Wide-field fundus photograph of an infant; 1440x1080; captured with the Natus RetCam Envision (130° field of view)
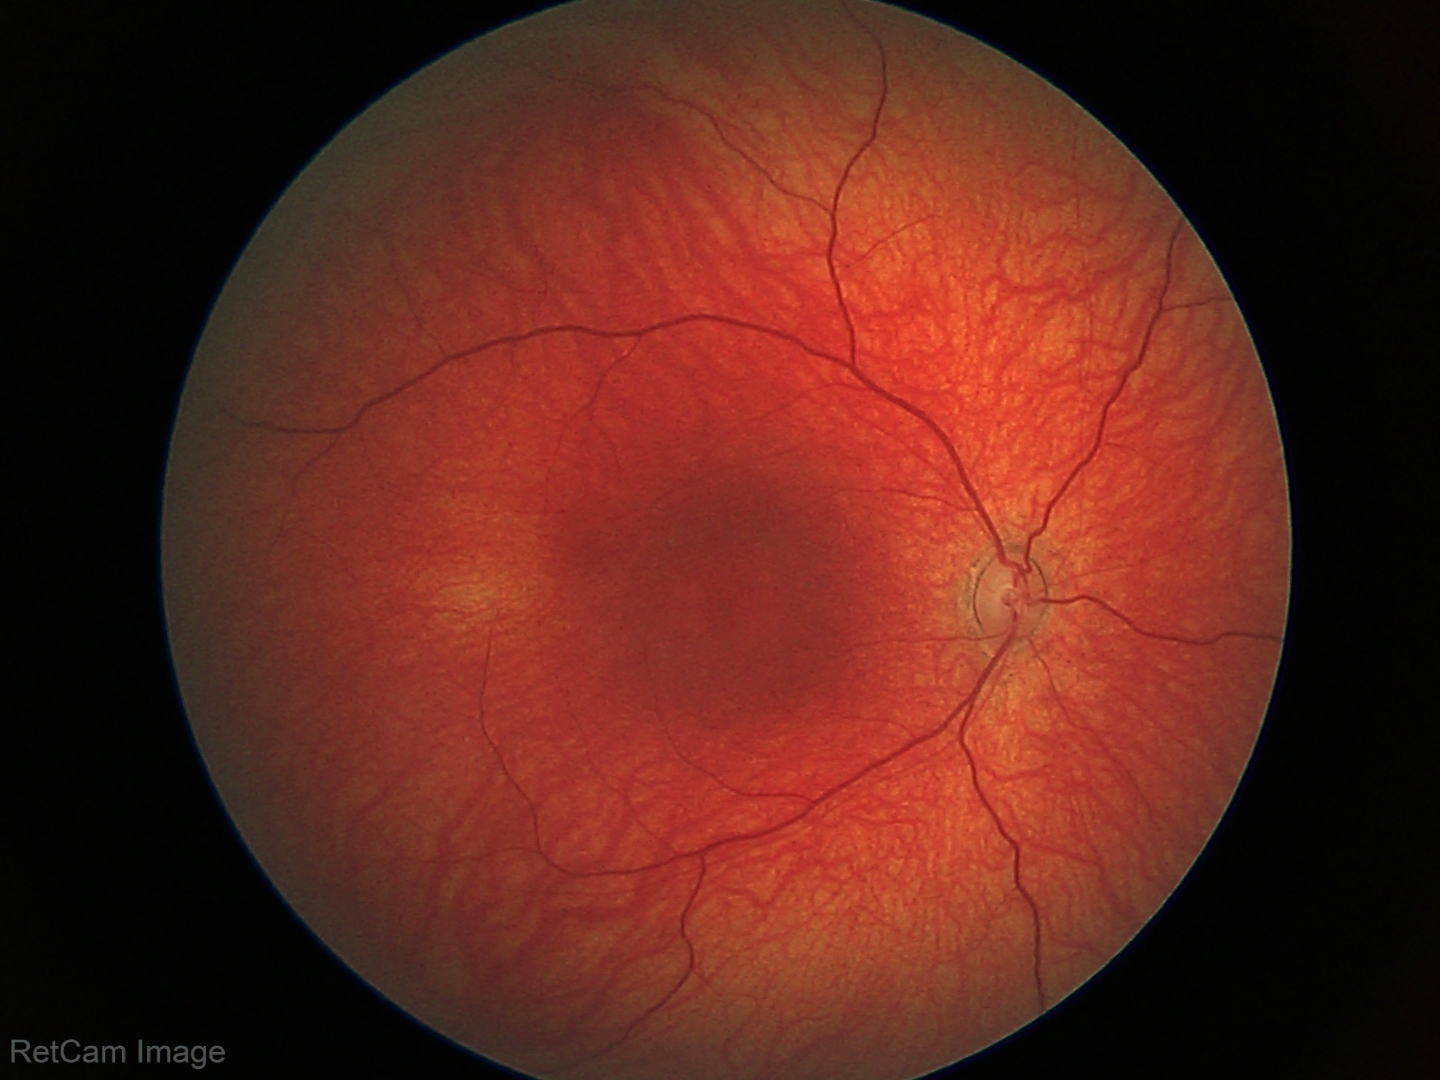
Screening diagnosis = no abnormalities.